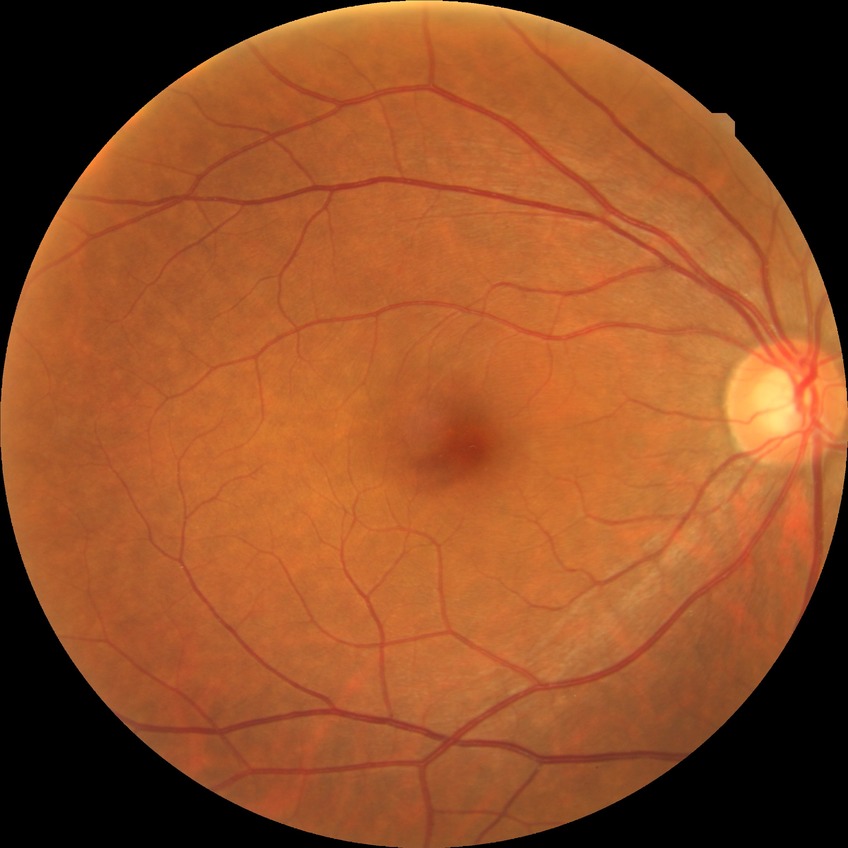 Findings:
• DR impression — negative for DR
• Davis DR grade — NDR